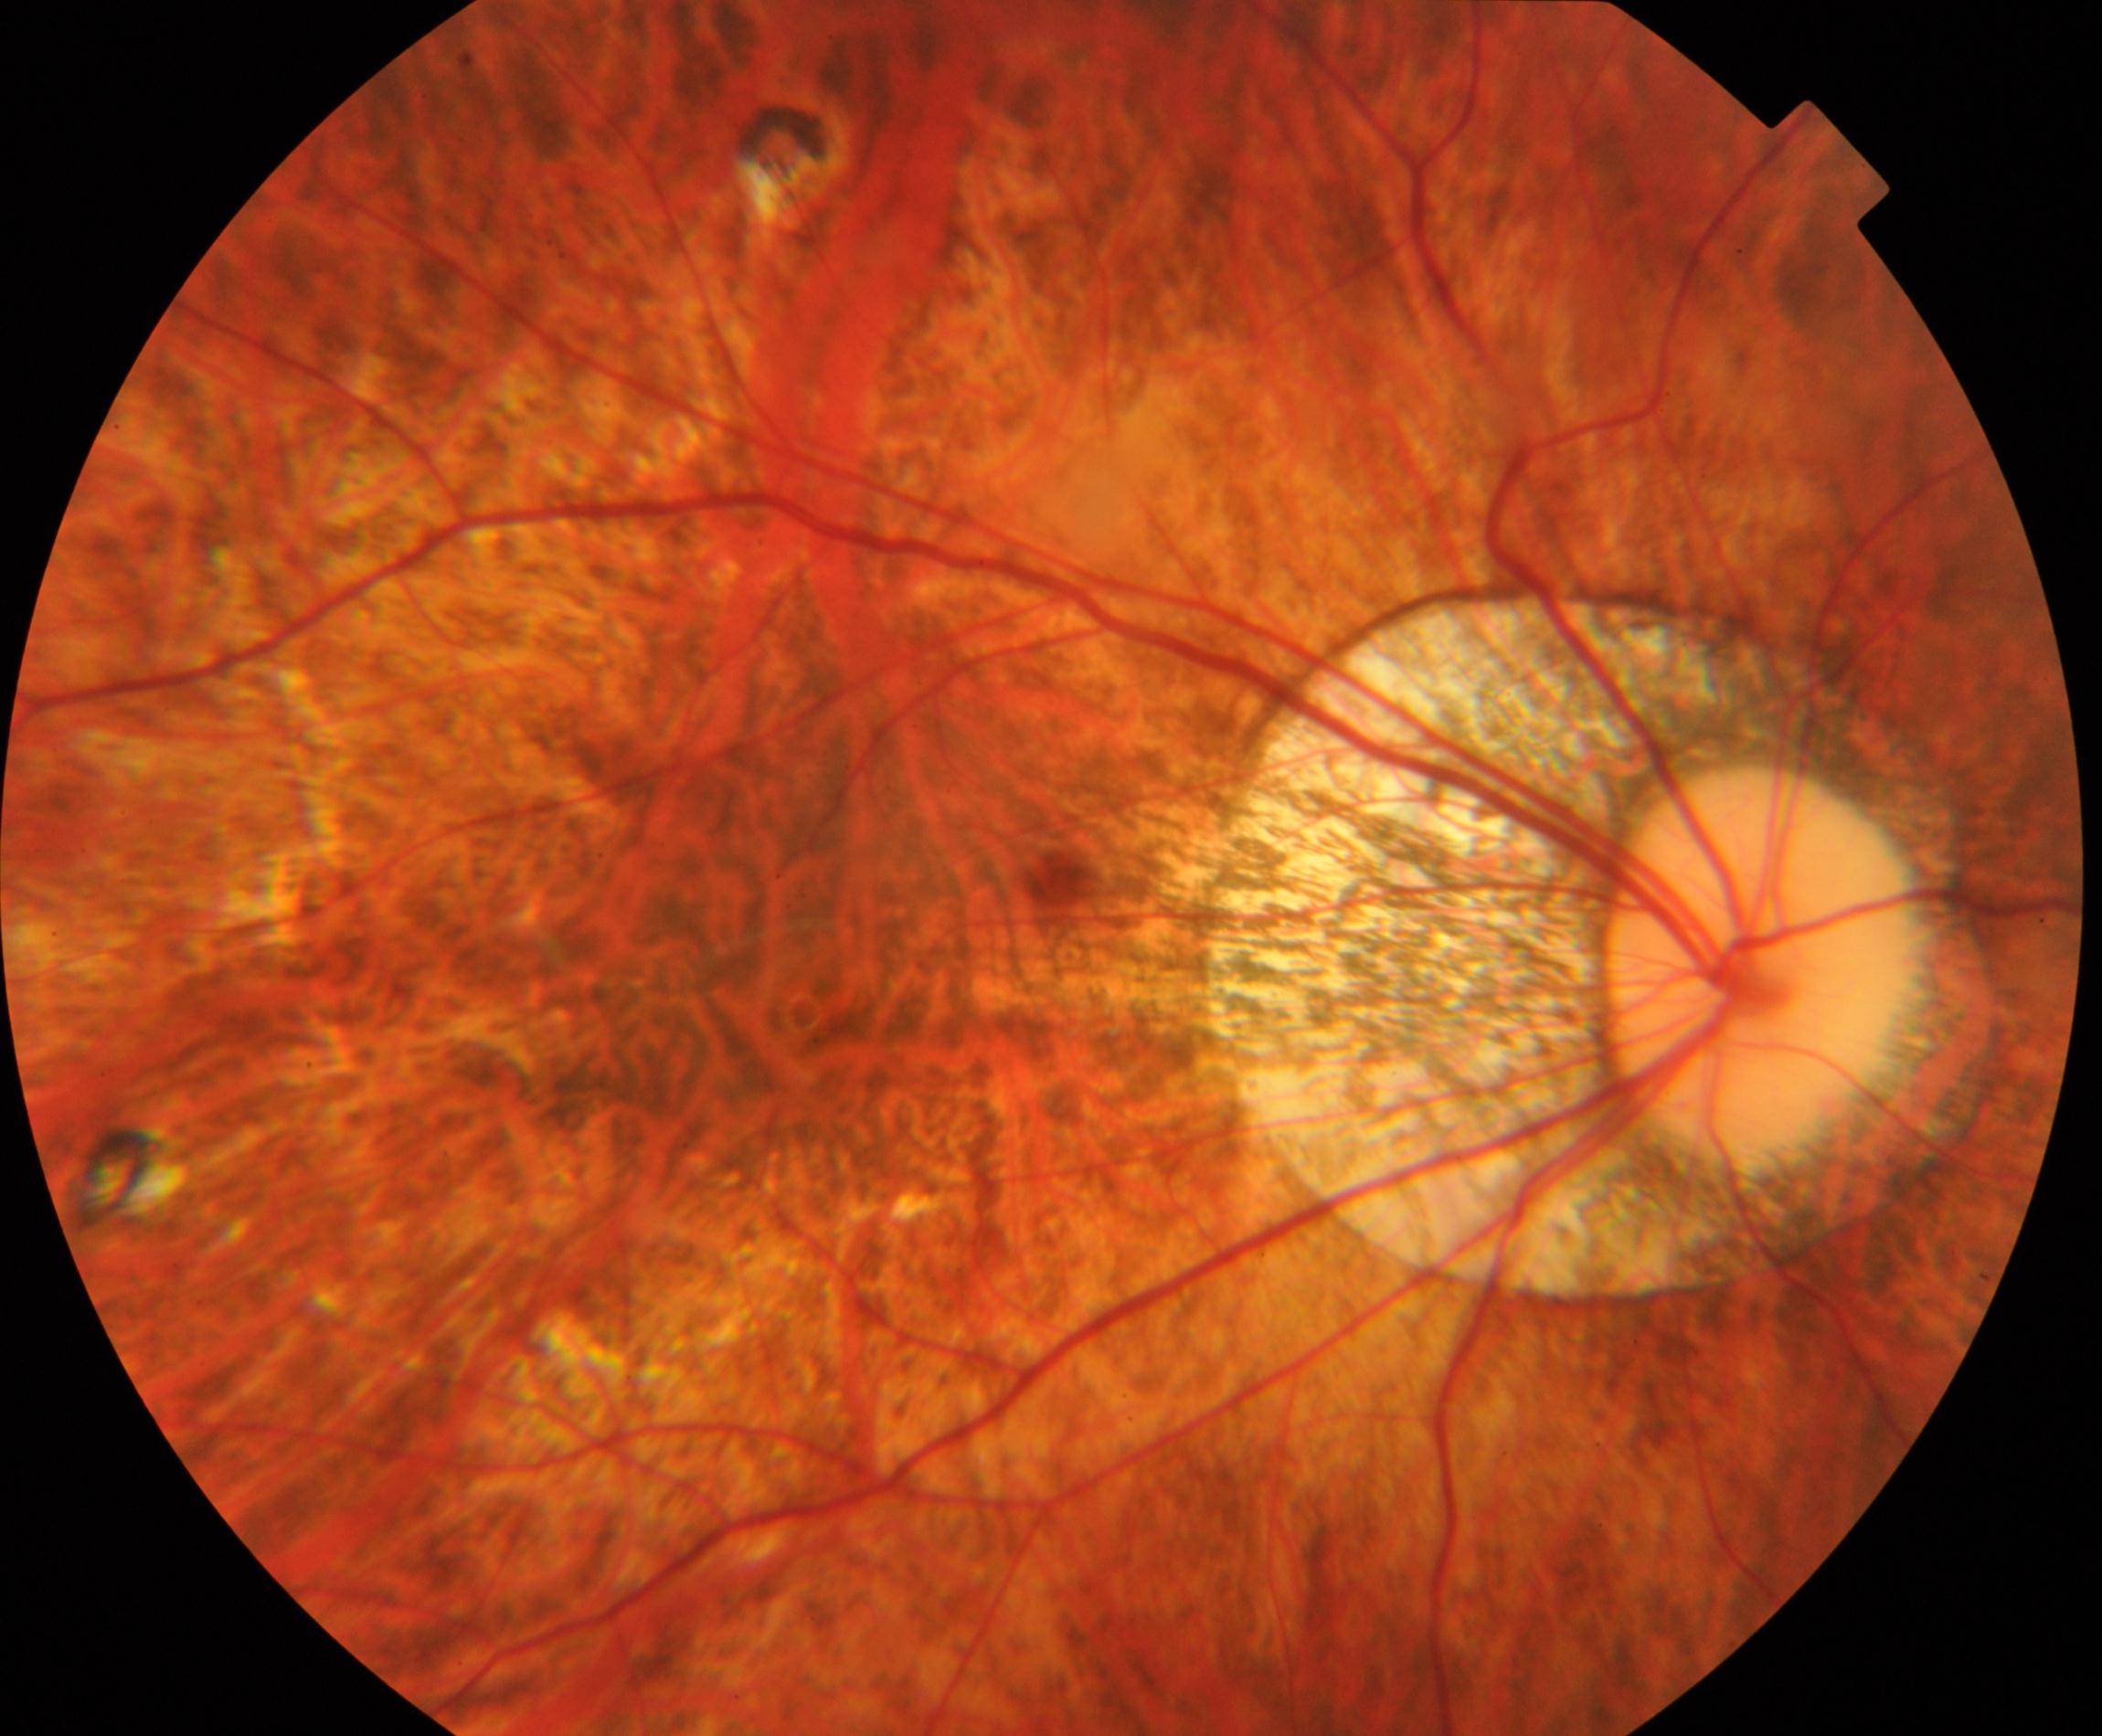

Findings: pathological myopia. Characterized by tessellated fundus with focal chorioretinal atrophy, Fuchs spot, lacquer cracks, choroidal neovascularization, or subretinal hemorrhage.